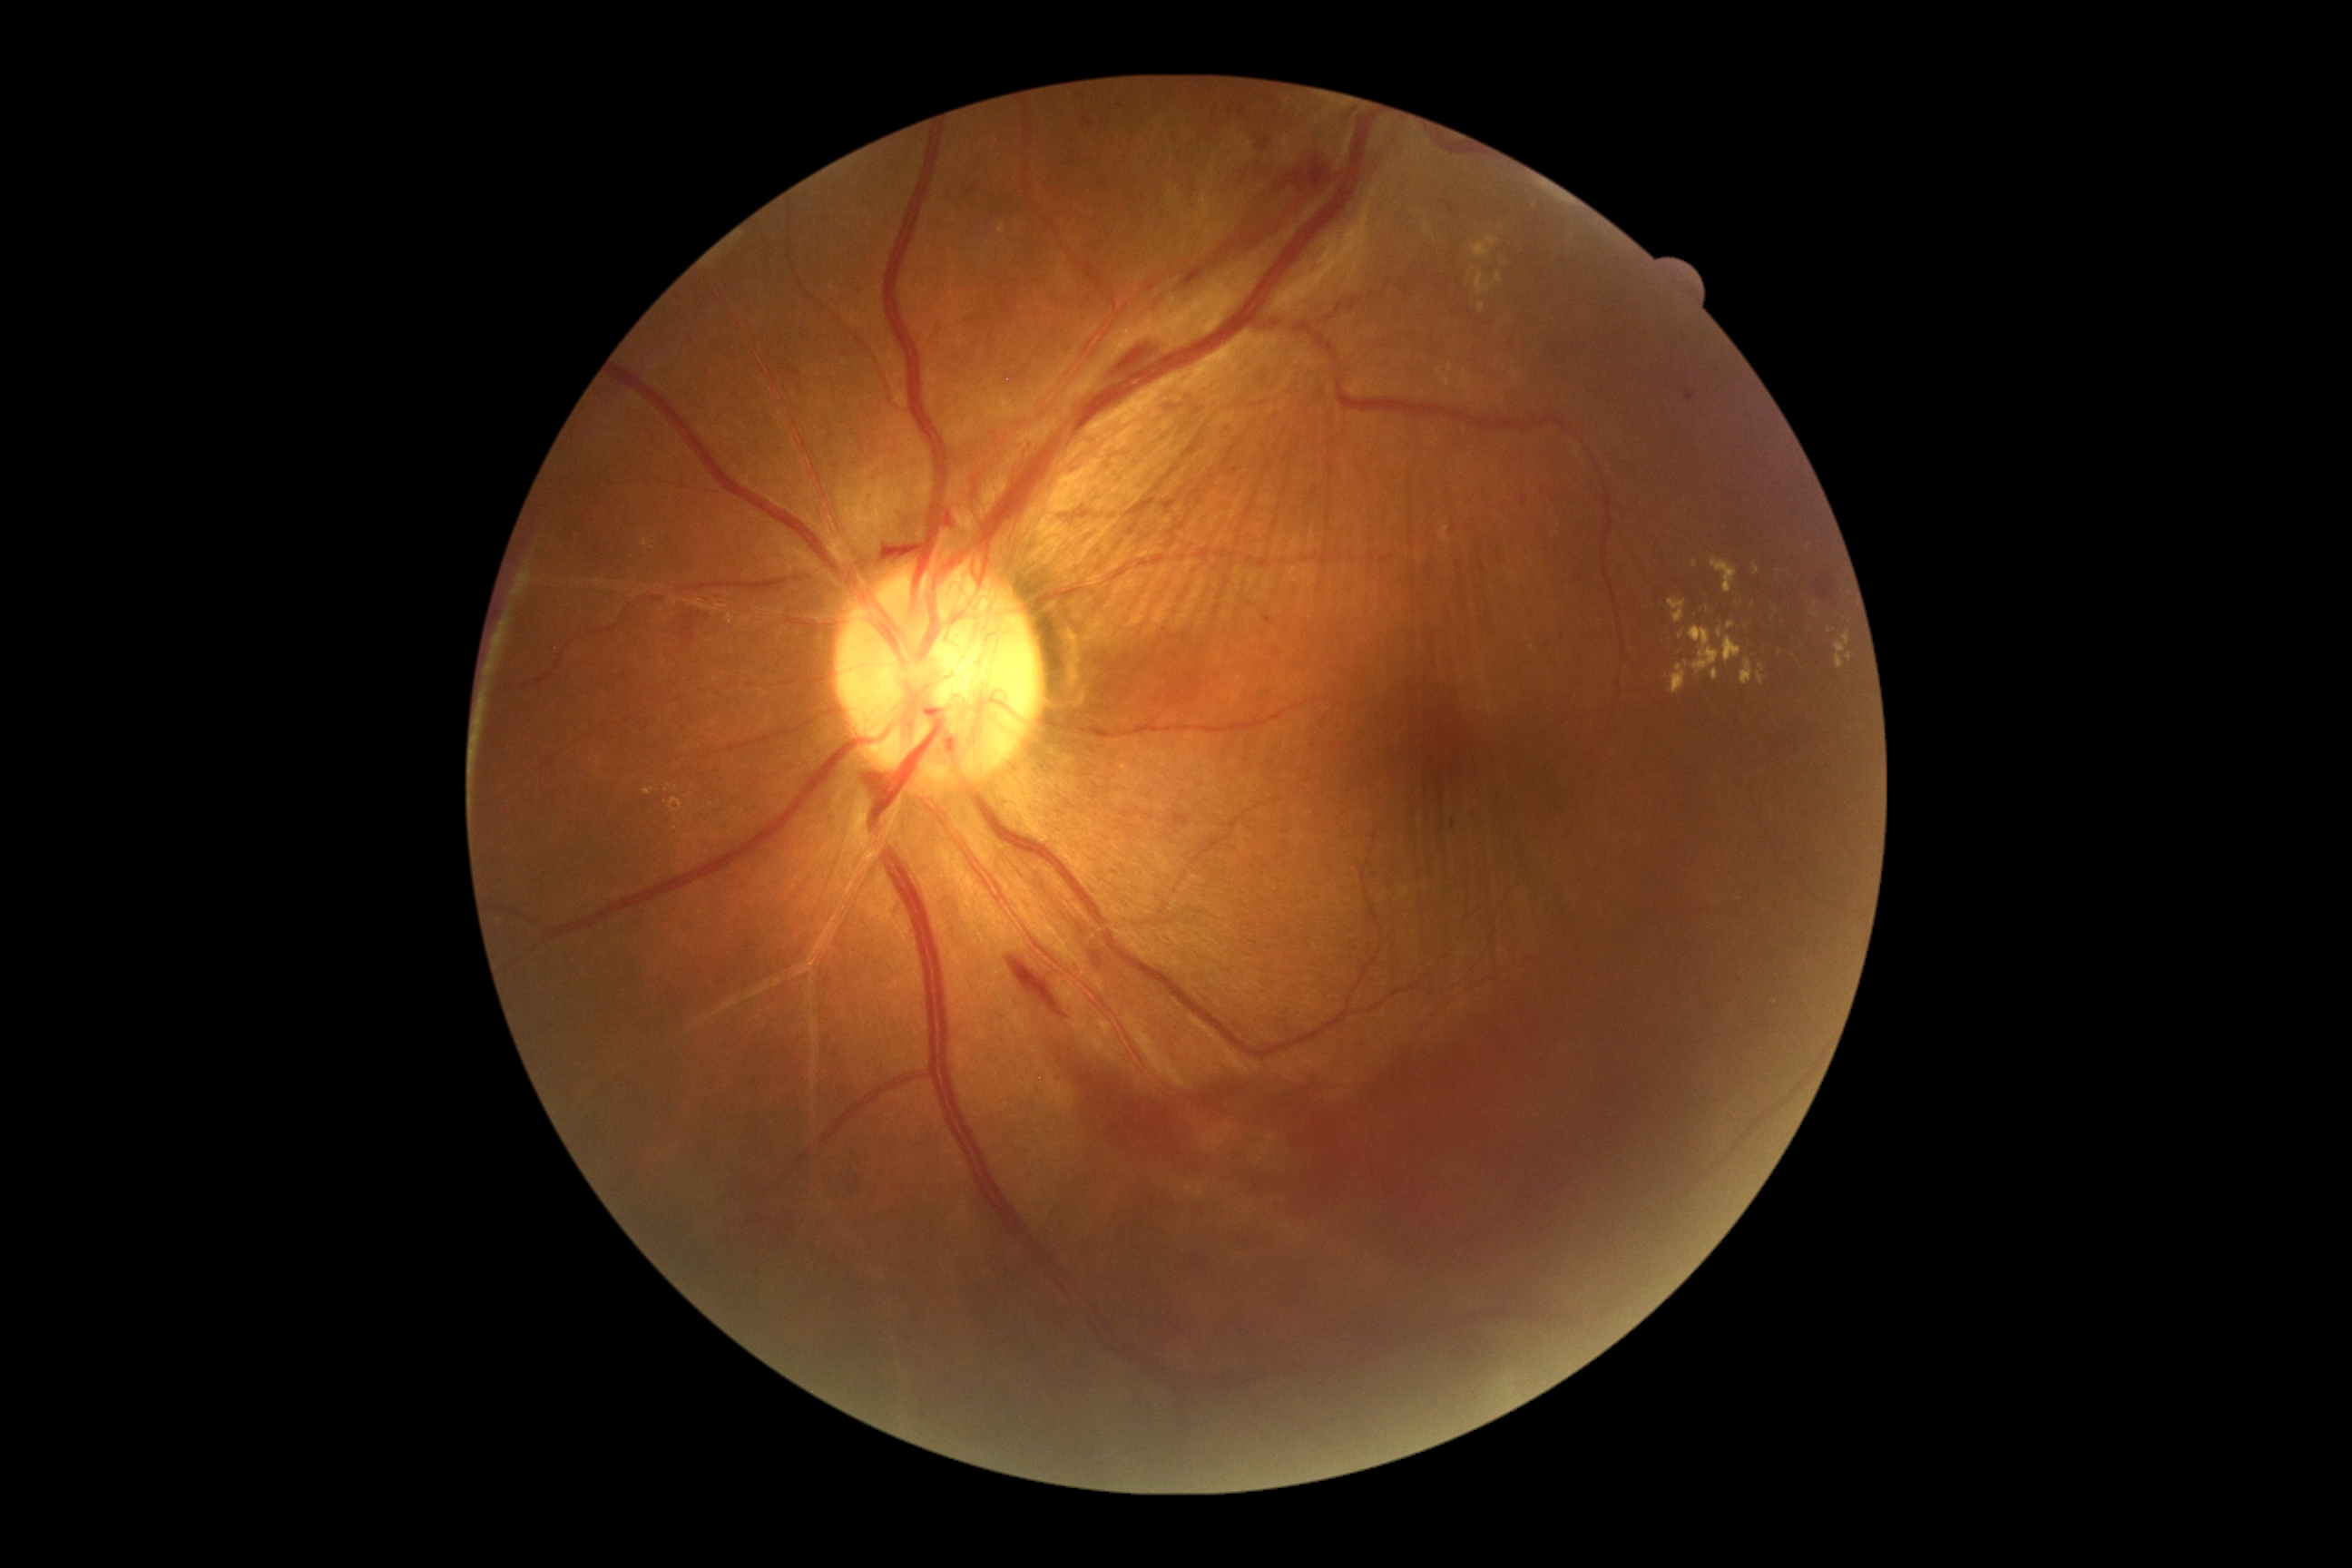 Annotations:
- DR class: proliferative diabetic retinopathy
- retinopathy grade: 4 (PDR)